FOV: 45 degrees
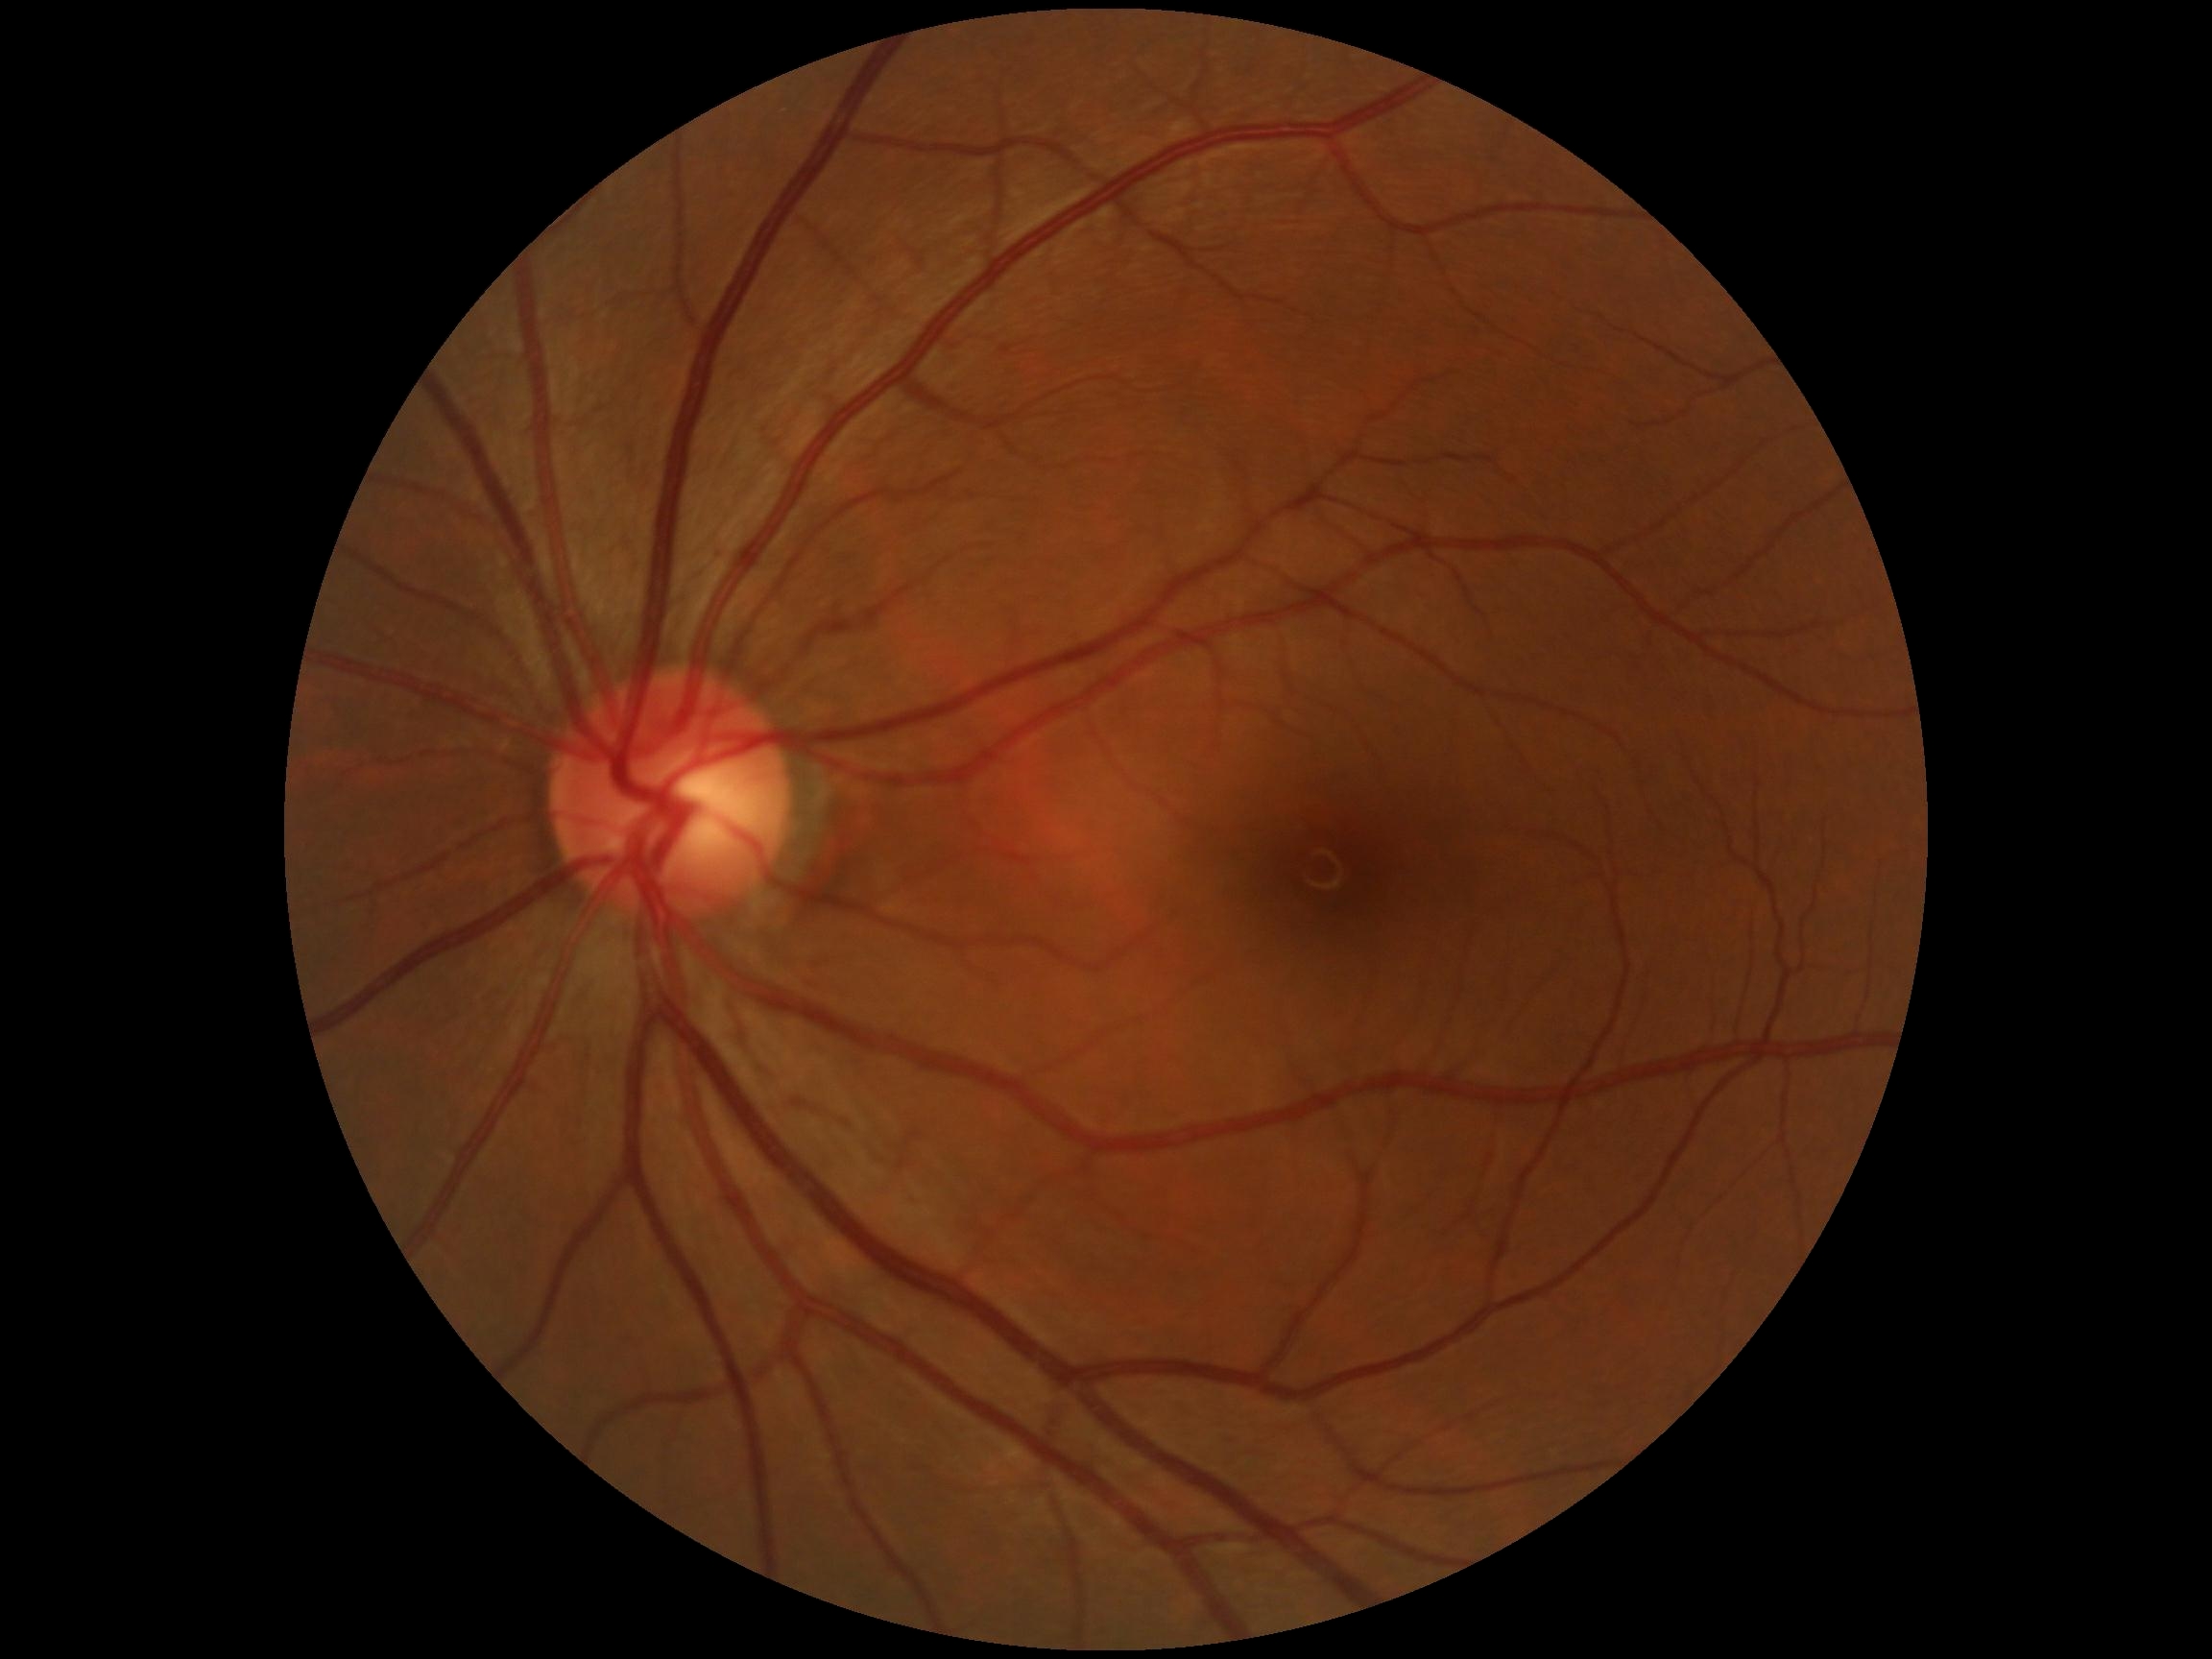 diabetic retinopathy: no apparent retinopathy (grade 0).